Ultra-widefield (UWF) fundus image. 1924x1556: 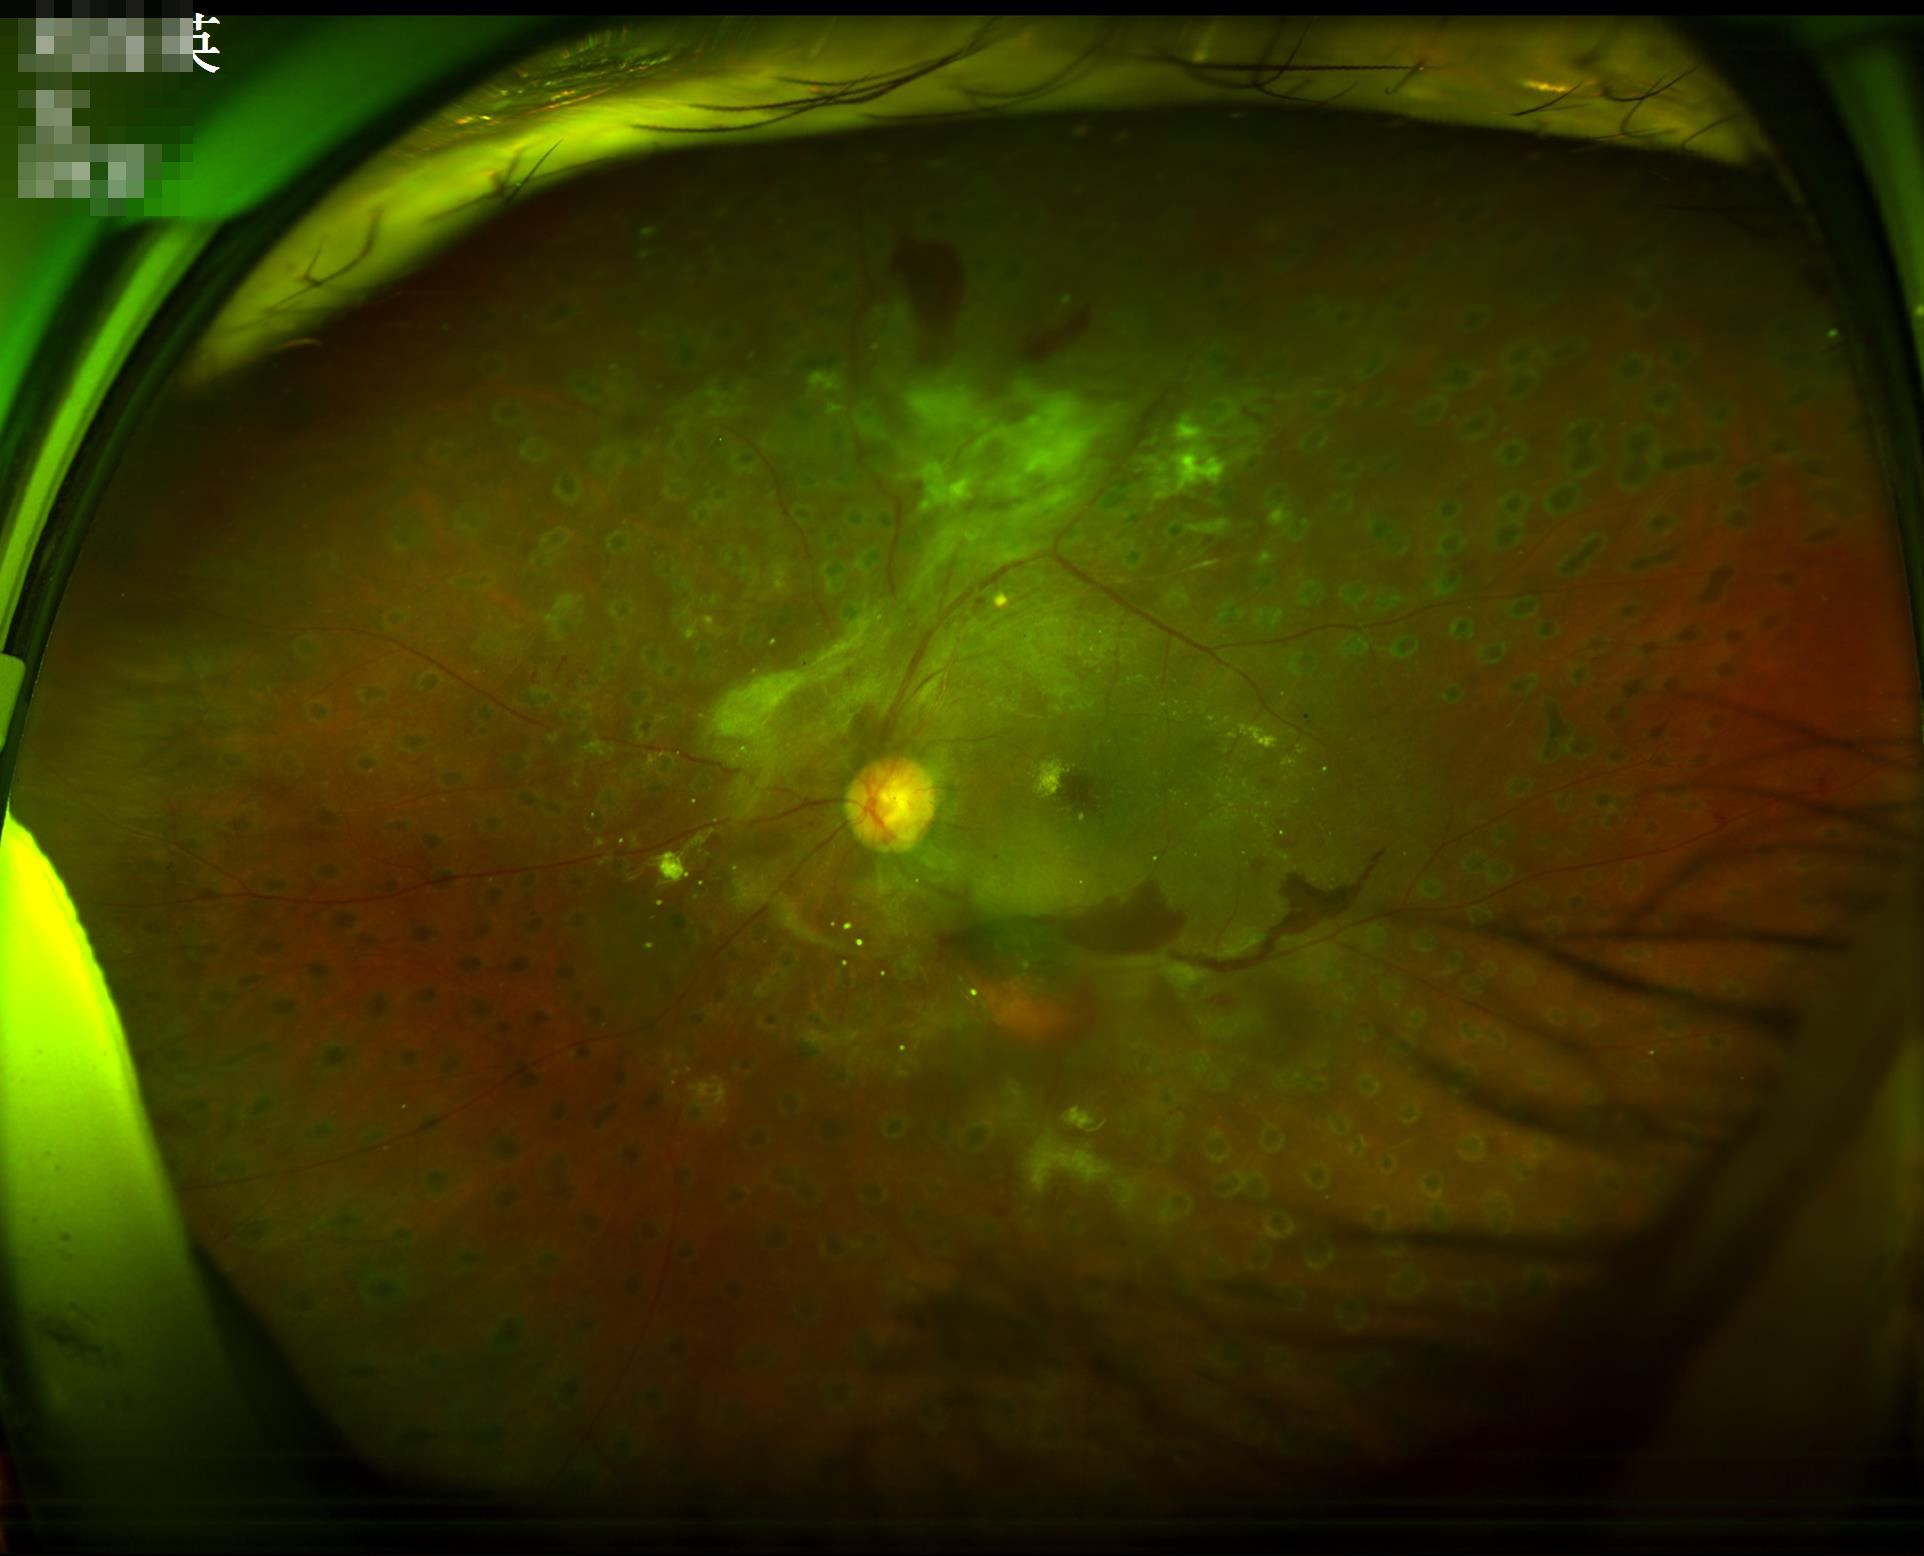
Quality grading: overall: poor and difficult to use diagnostically; illumination: over- or under-exposed; clarity: sharp throughout the field; contrast: wide intensity range, structures distinguishable.